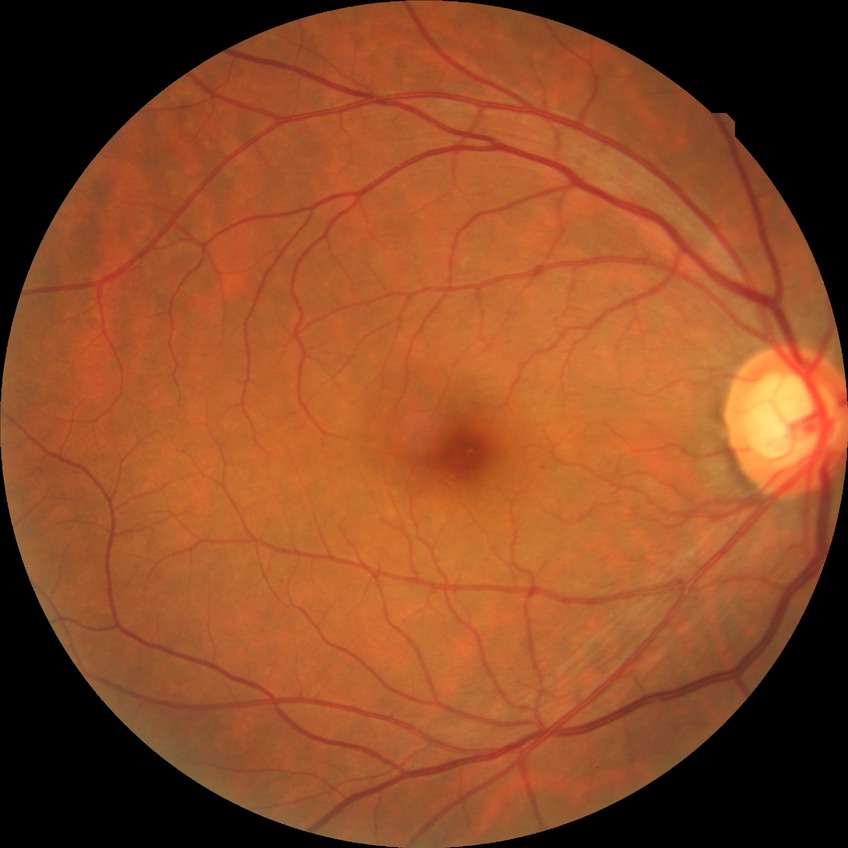 Diabetic retinopathy (DR): simple diabetic retinopathy (SDR).